45 degree fundus photograph — 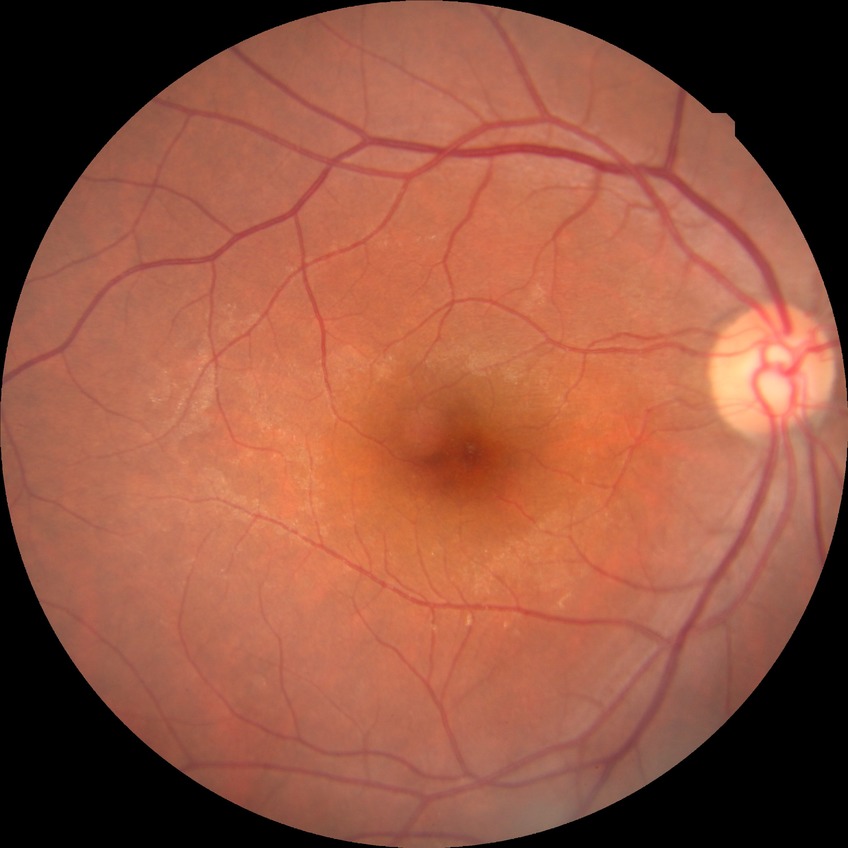 diabetic retinopathy stage@no diabetic retinopathy.